Tabletop color fundus camera image · image size 412x310: 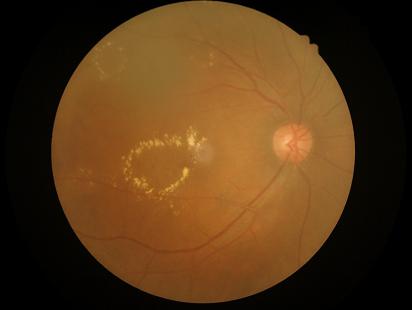

Quality assessment: contrast: reduced; focus: reduced; overall: low; illumination: even.